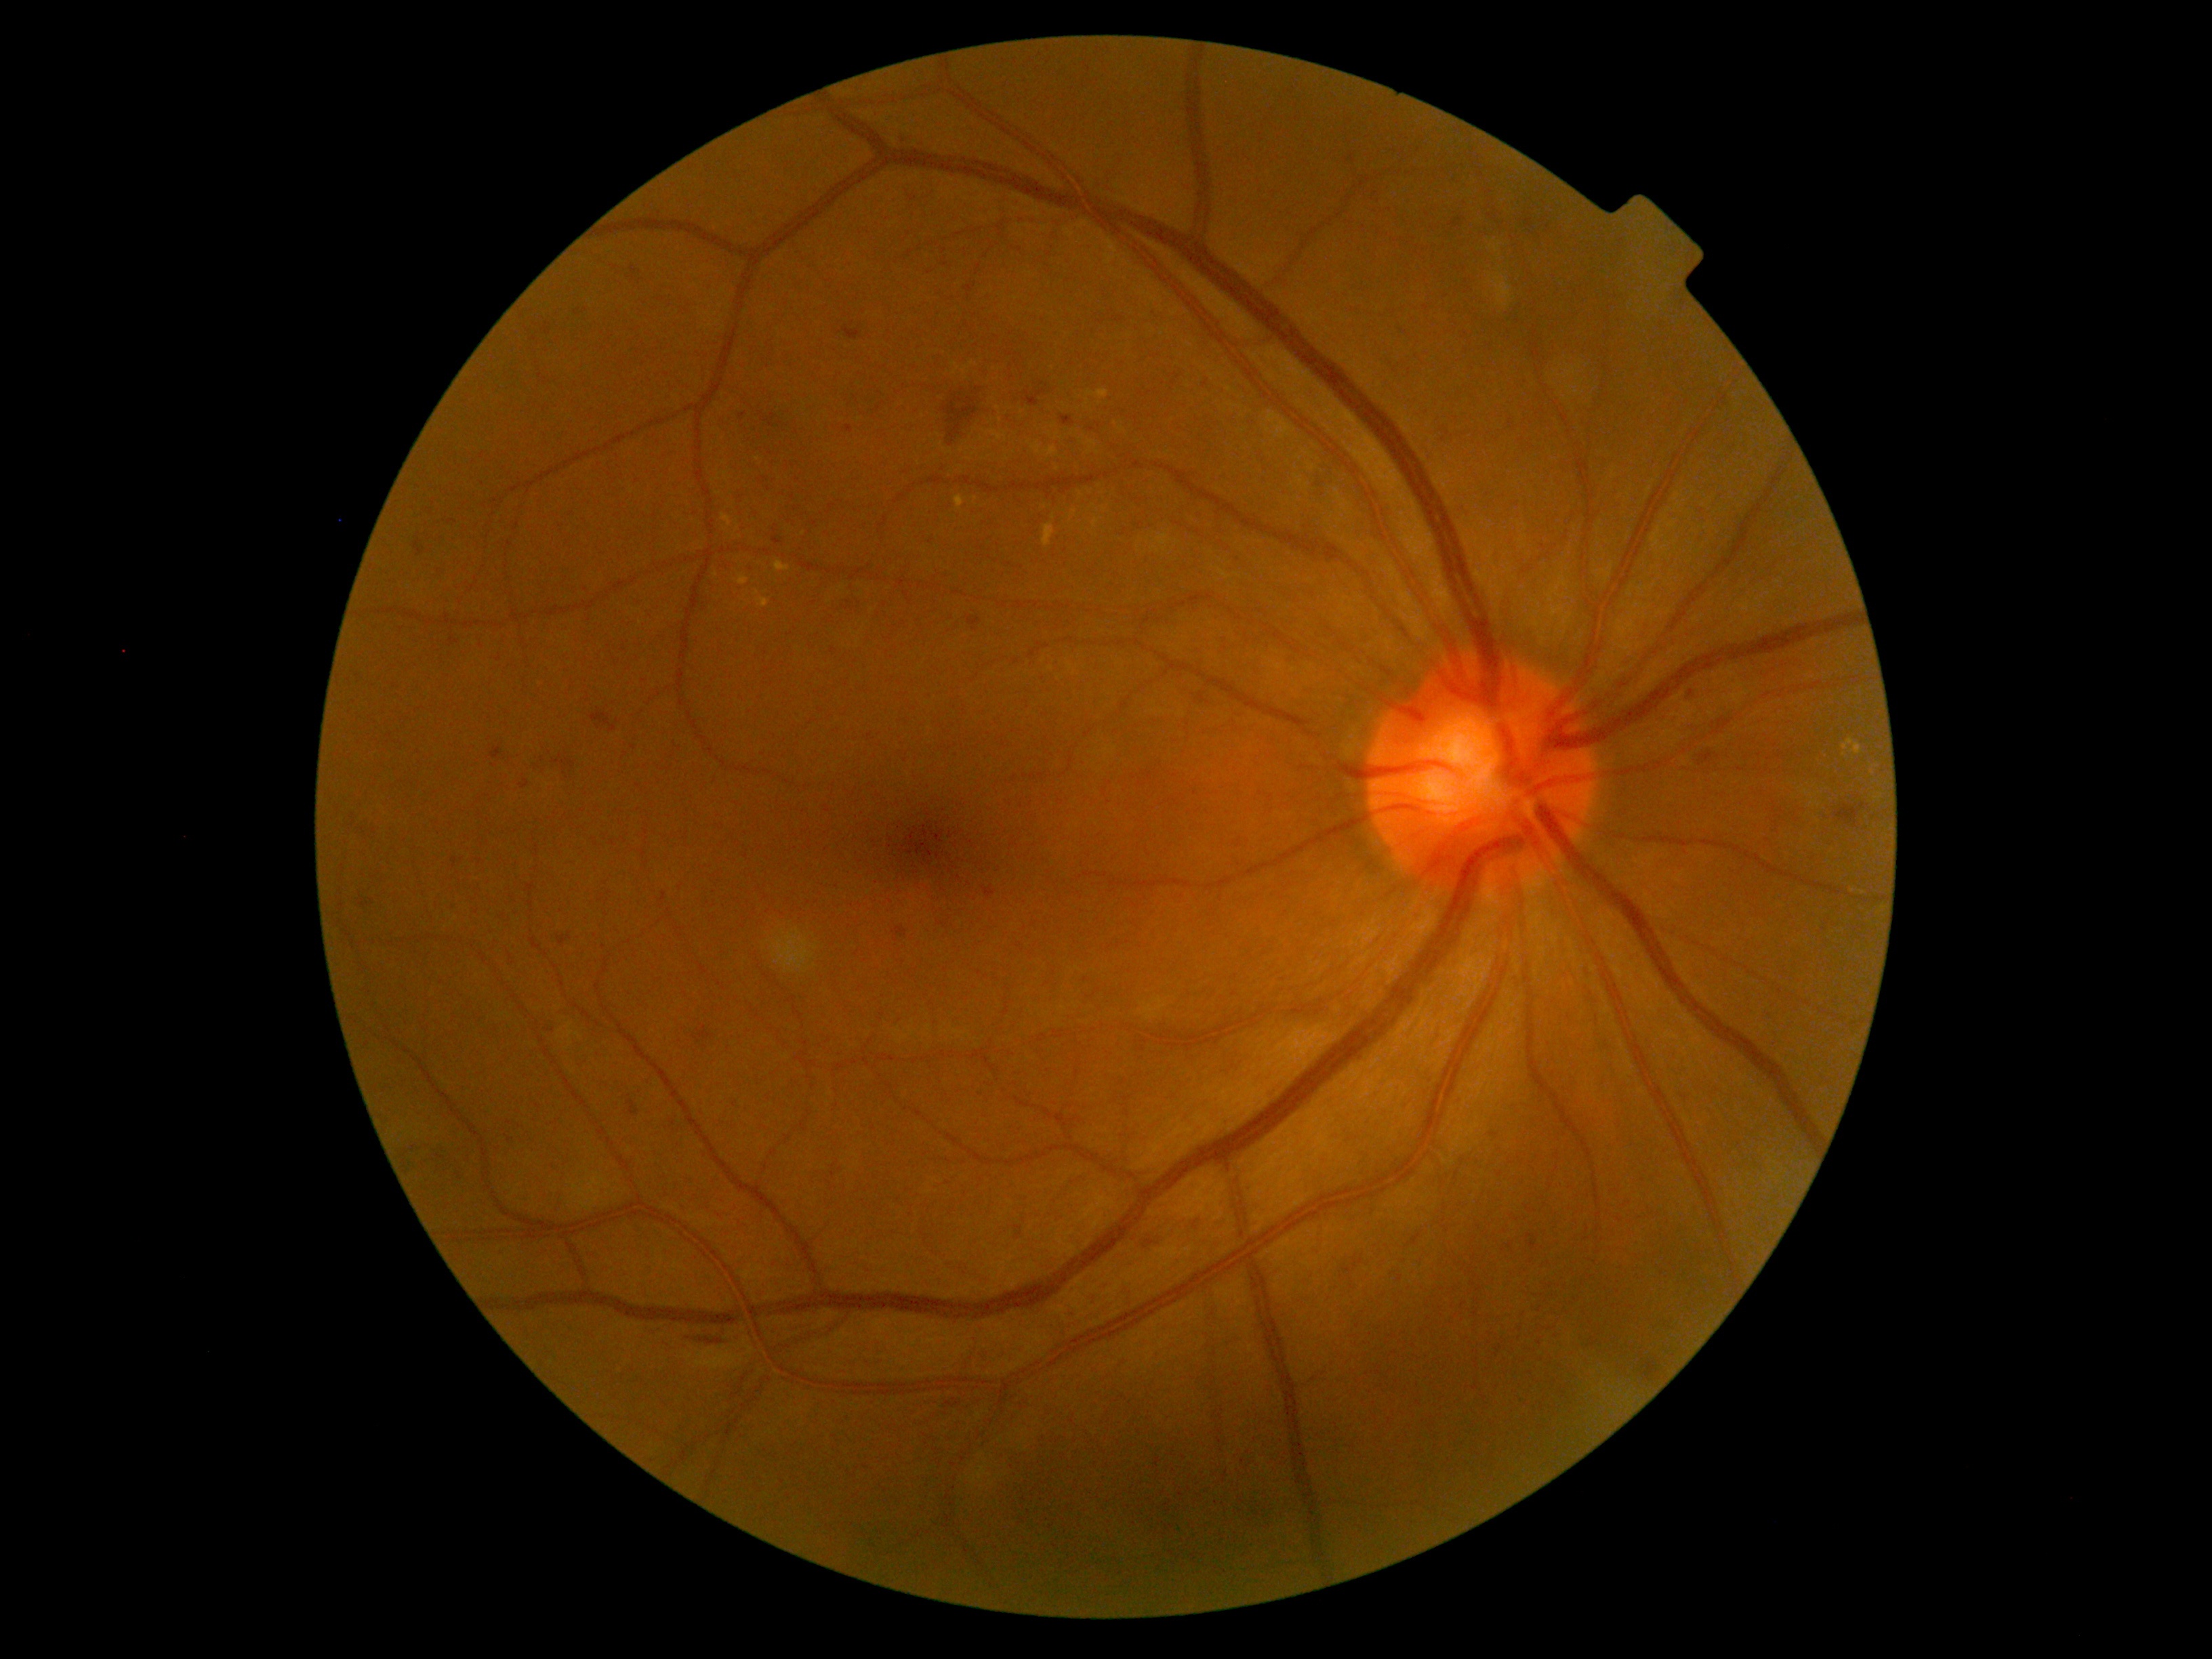
DR severity is grade 2 (moderate NPDR). HEs (partial list) at 1490,1132,1498,1138 | 982,887,996,901 | 552,757,563,765 | 1343,1254,1364,1275 | 1835,803,1870,830 | 436,1154,445,1161 | 1496,1348,1501,1357 | 761,415,775,428 | 558,935,570,945 | 1015,1226,1023,1238 | 699,1025,712,1042 | 1025,390,1047,407 | 700,1338,723,1345. Additional small HEs near (x=511, y=1140) | (x=1540, y=1311) | (x=1399, y=1280) | (x=1540, y=1344) | (x=542, y=760).